45-degree field of view. 2212x1659px: 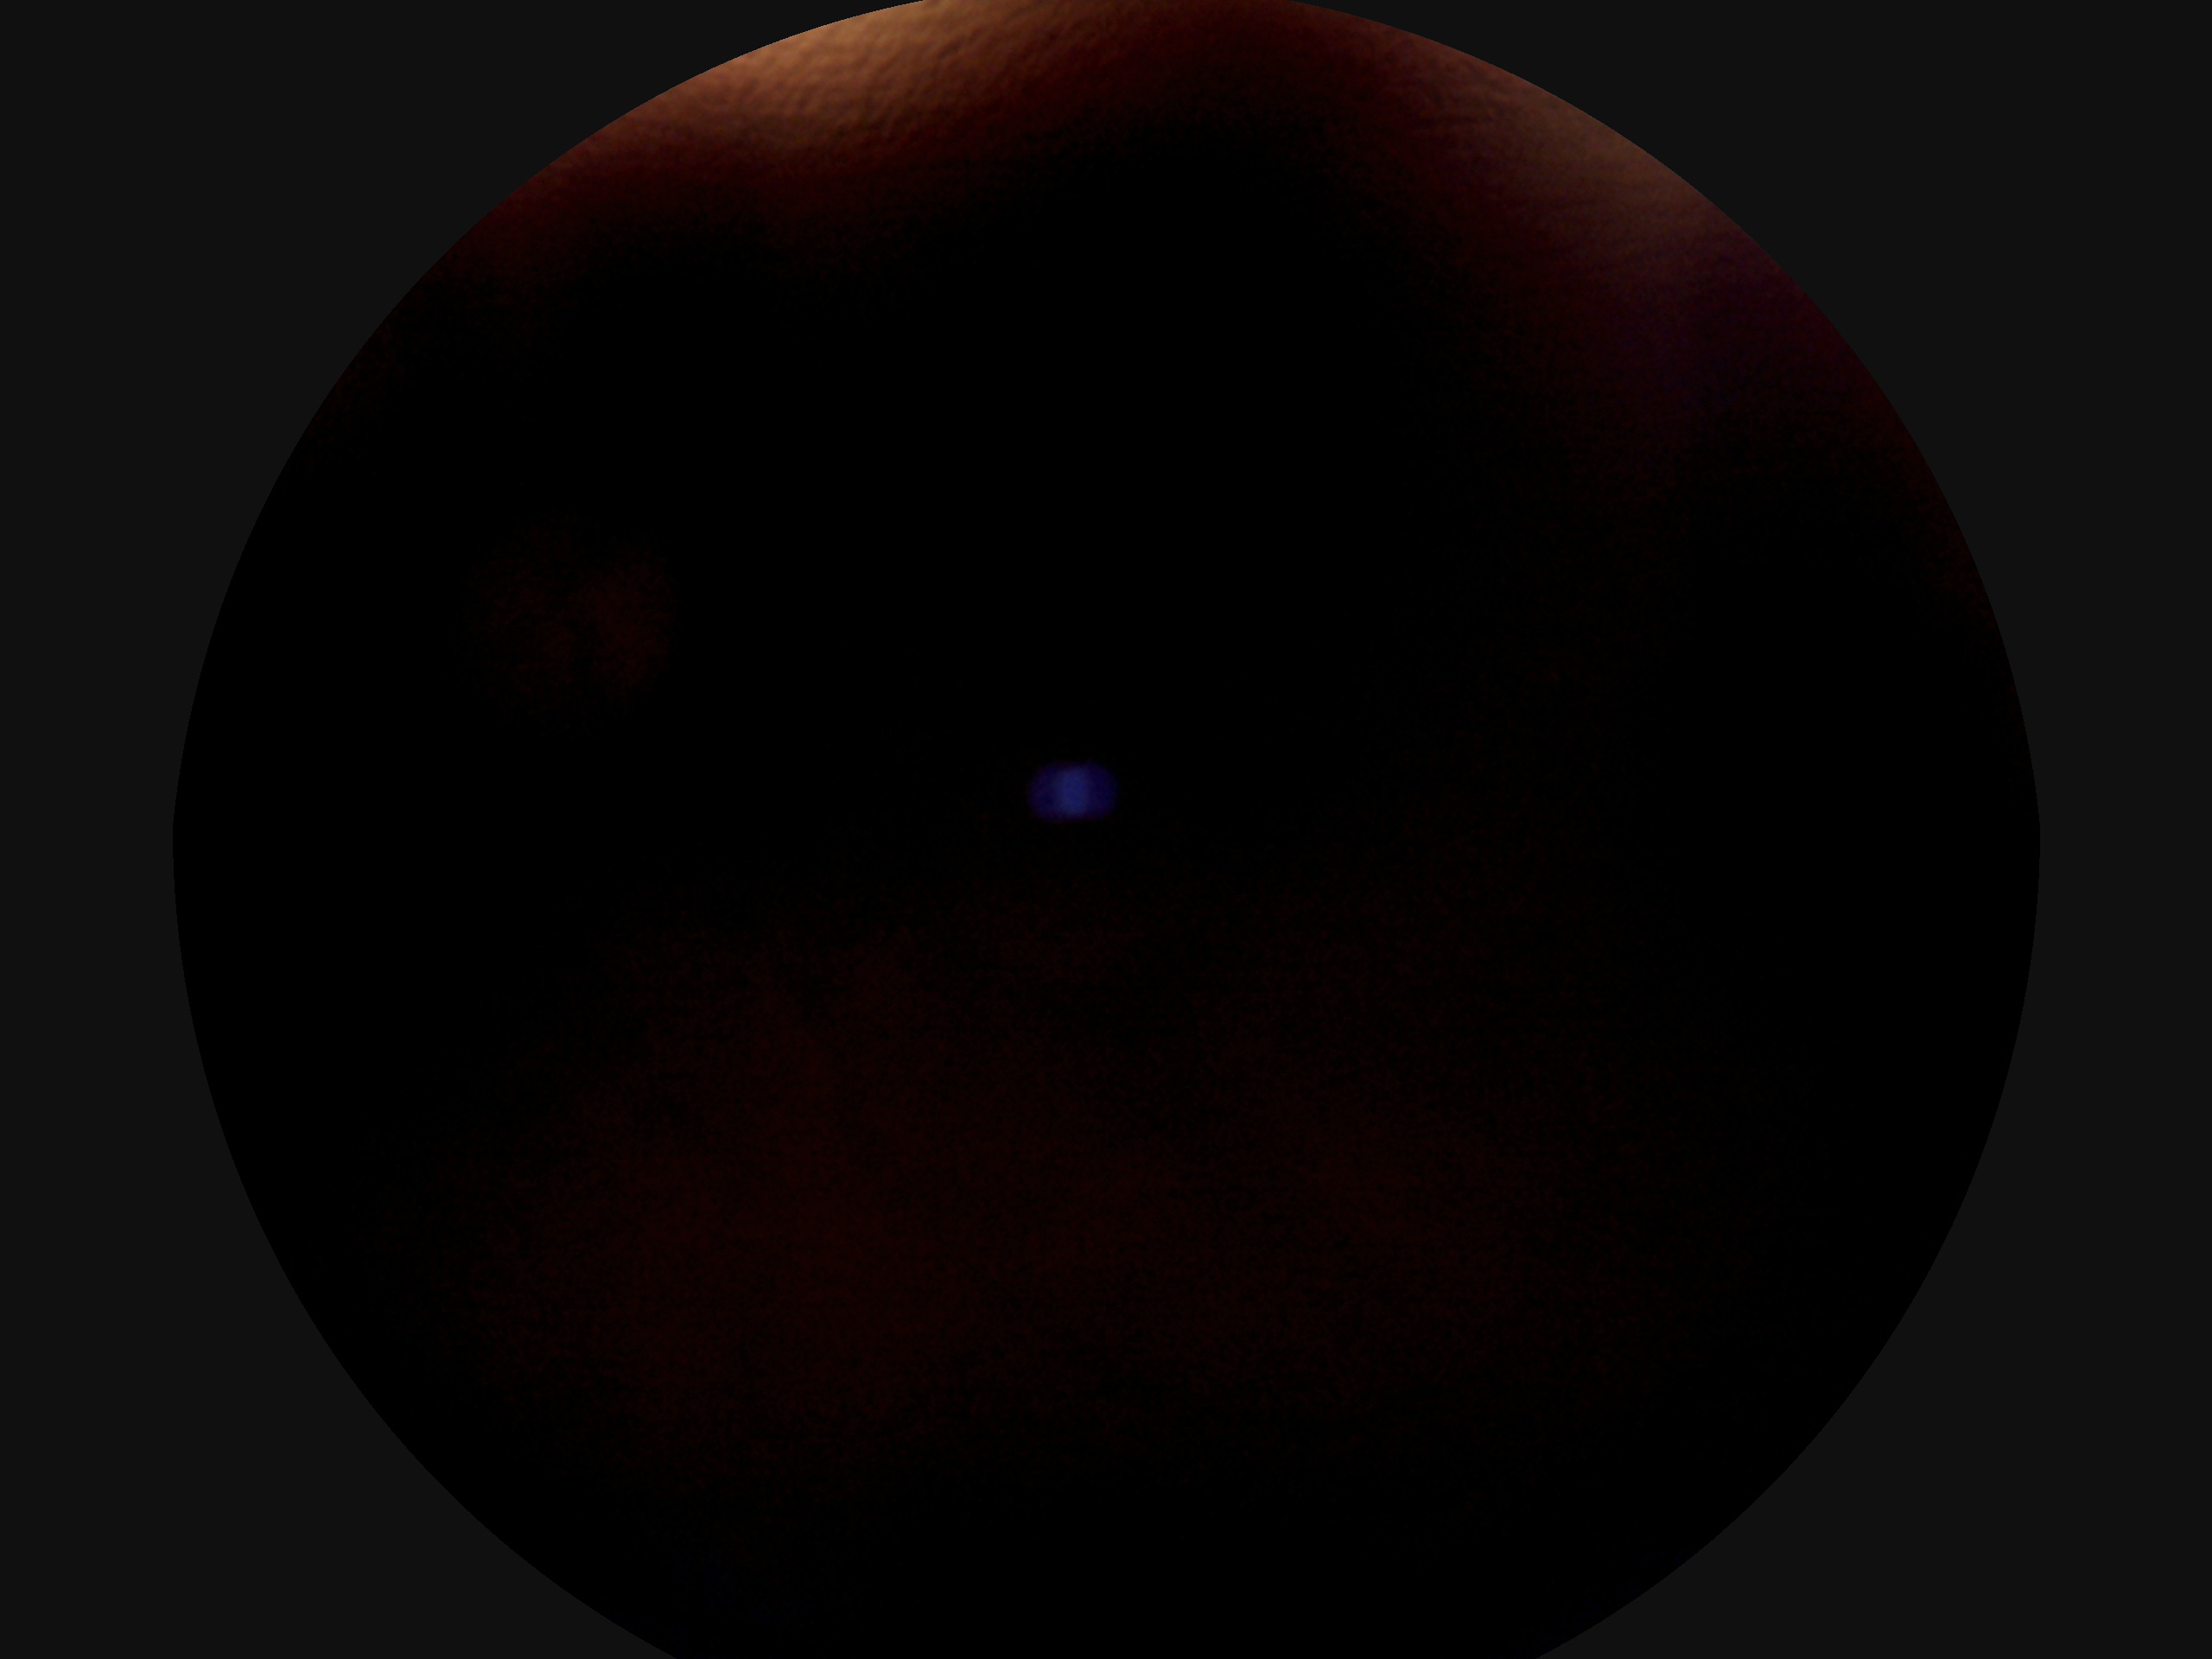 • retinopathy grade — ungradable